CFP.
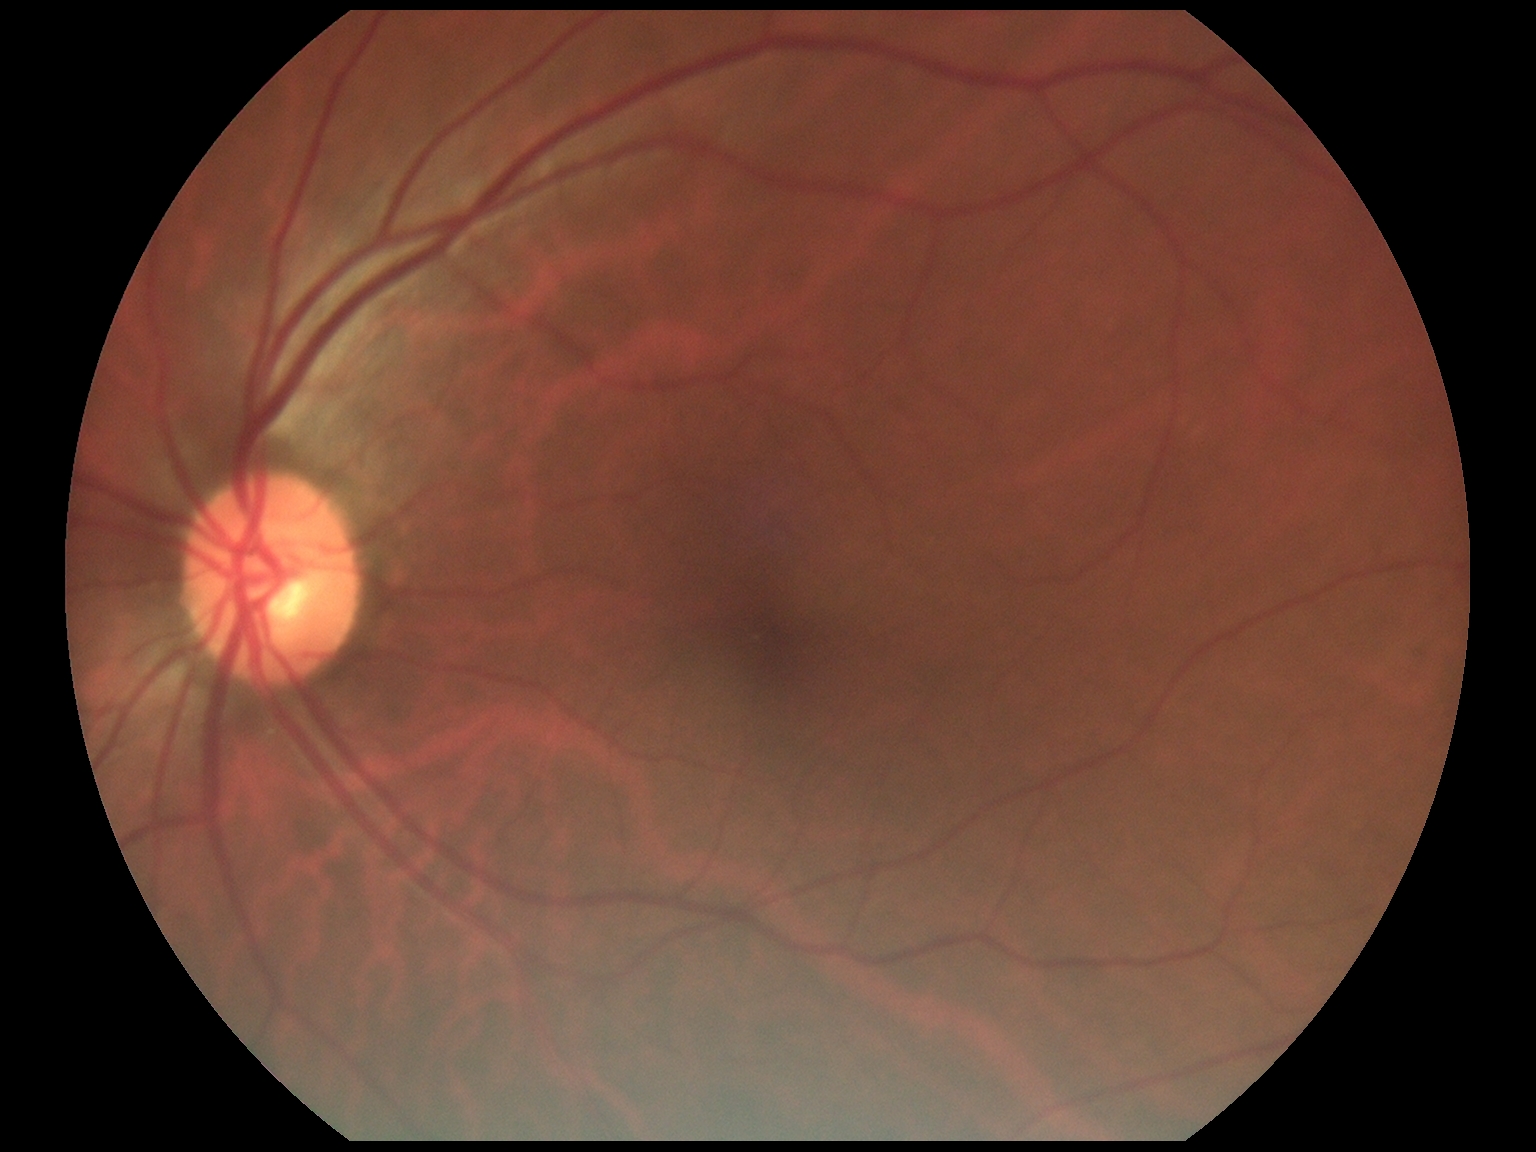

Diabetic retinopathy (DR) is no apparent diabetic retinopathy (grade 0).